Captured after pupil dilation. Macula-centered. 2361x1568. Captured on a Kowa VX-10α fundus camera:
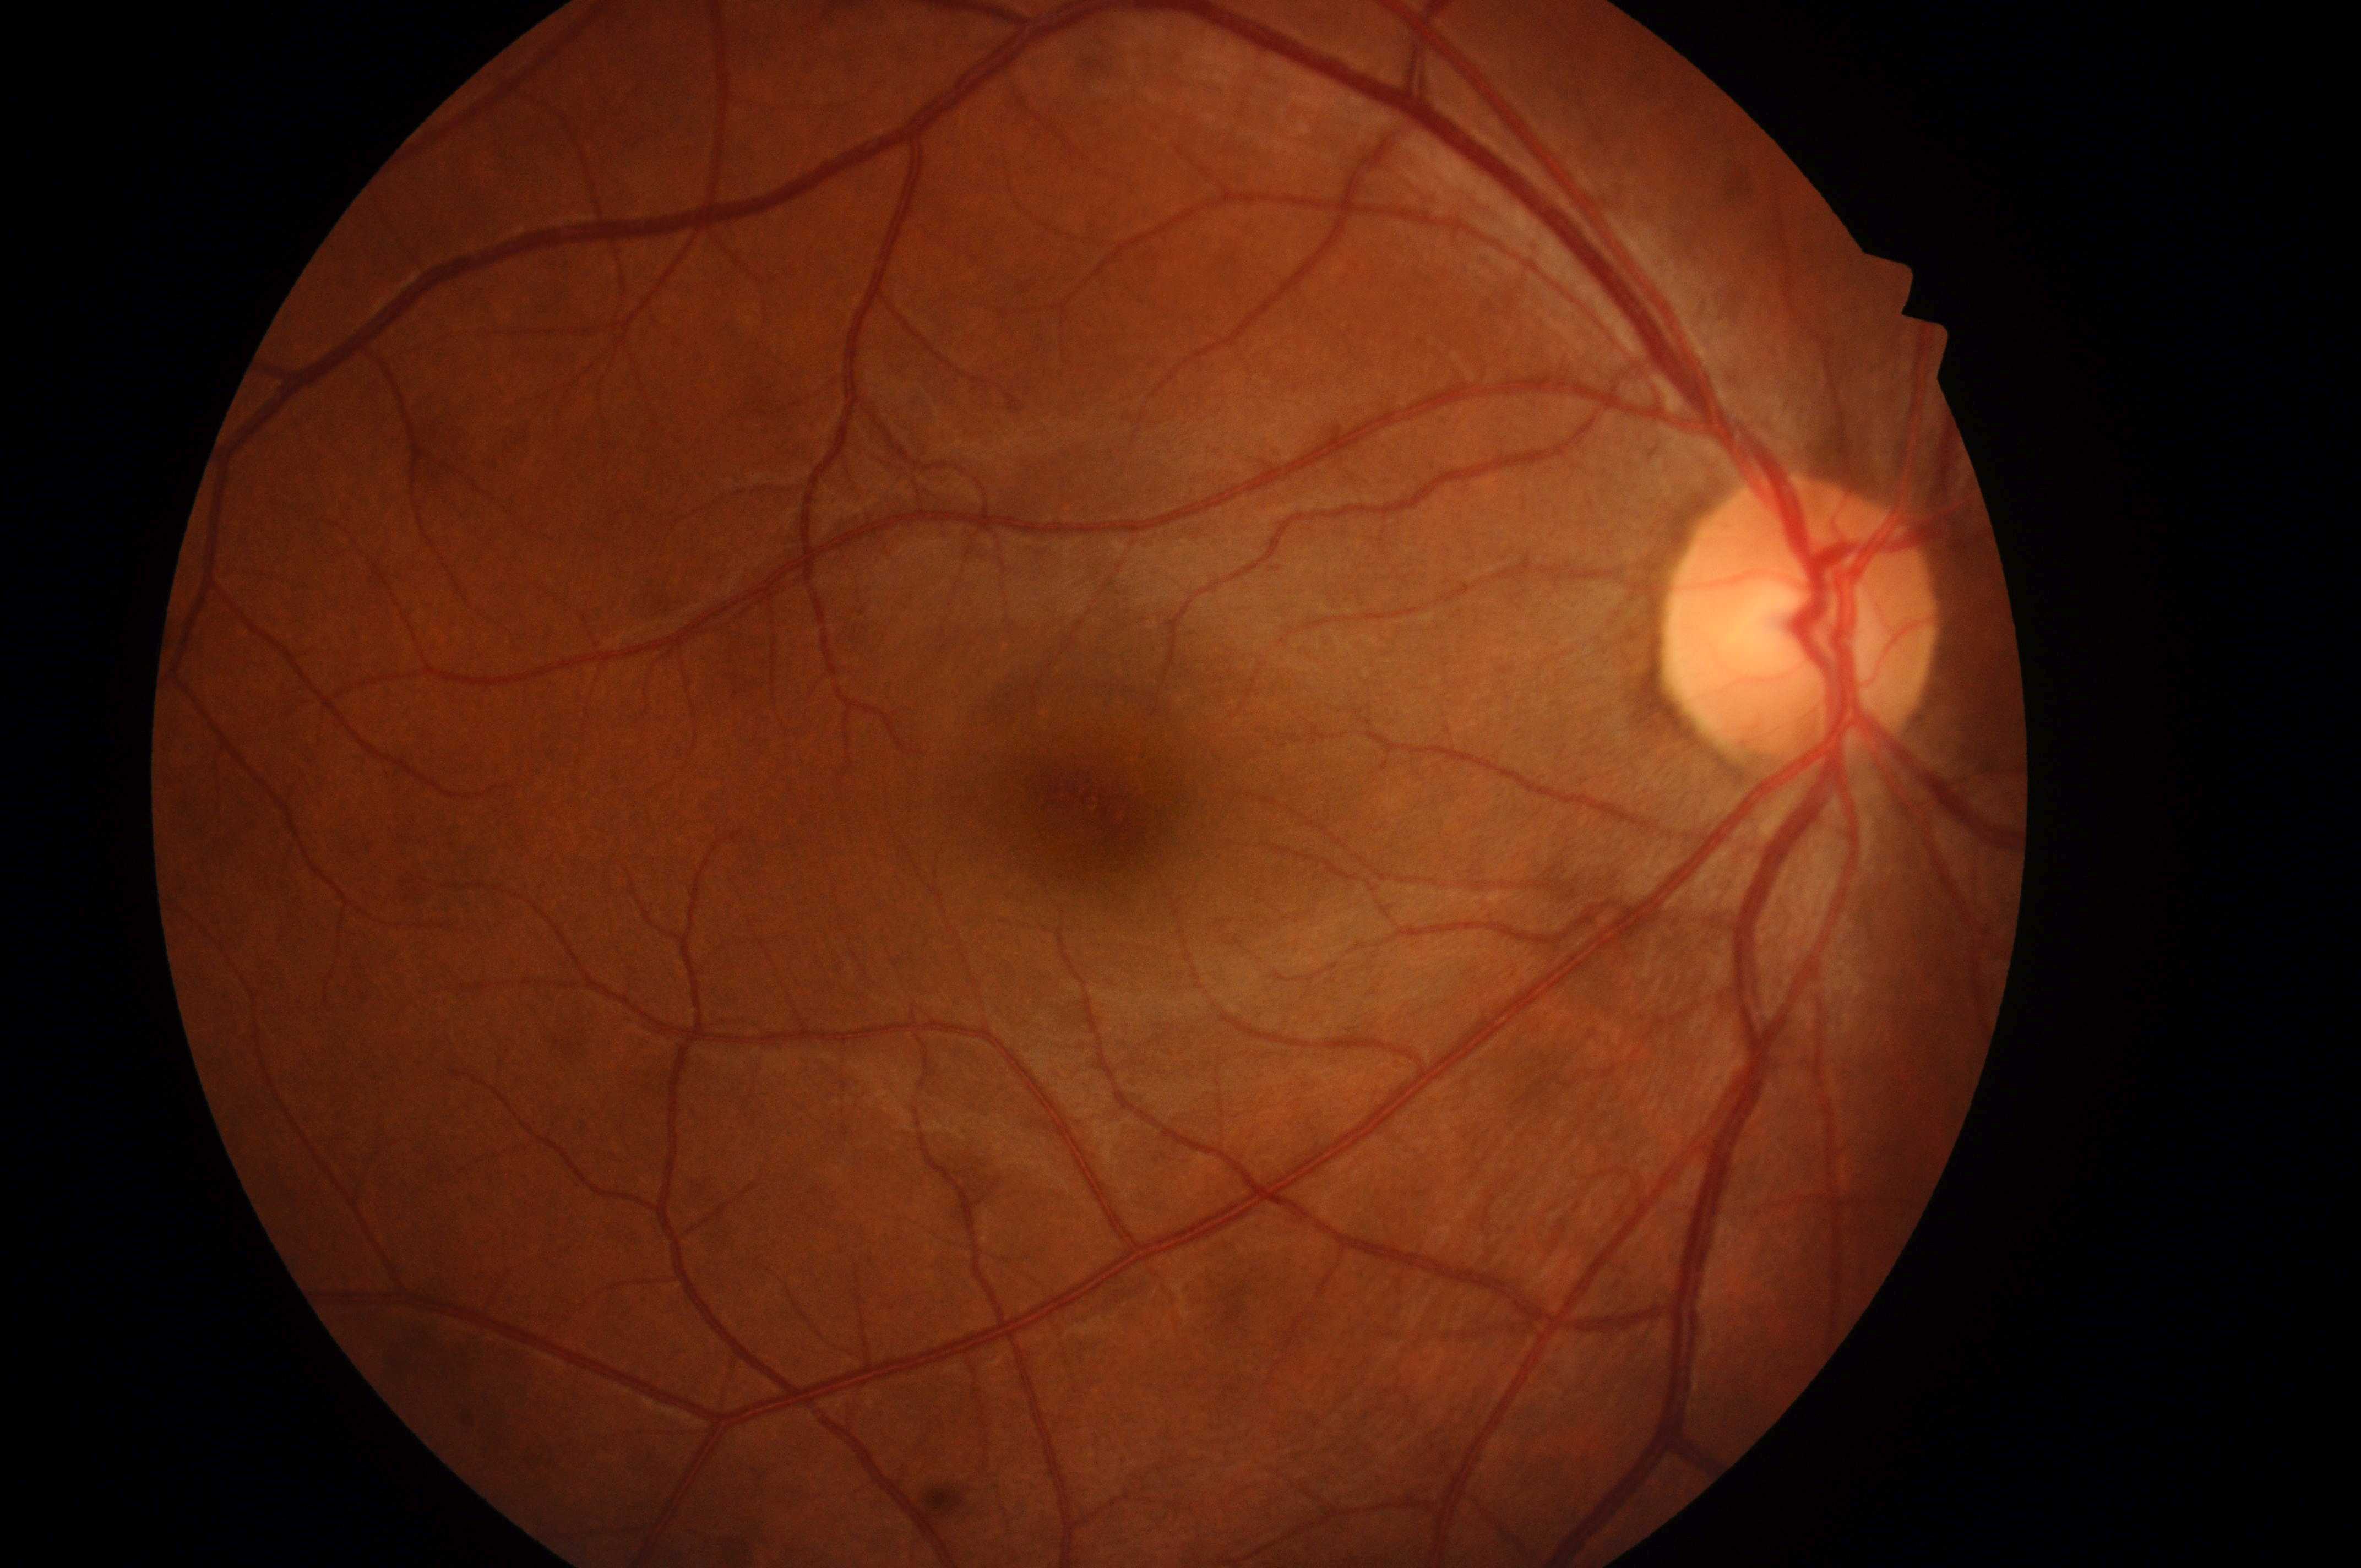
diabetic retinopathy (DR) = grade 0 (no apparent retinopathy) | diabetic macular edema (DME) = grade 0 (no risk) | disc center = [1797, 635] | foveal center = [1089, 804] | laterality = right.